Nonmydriatic fundus photograph — 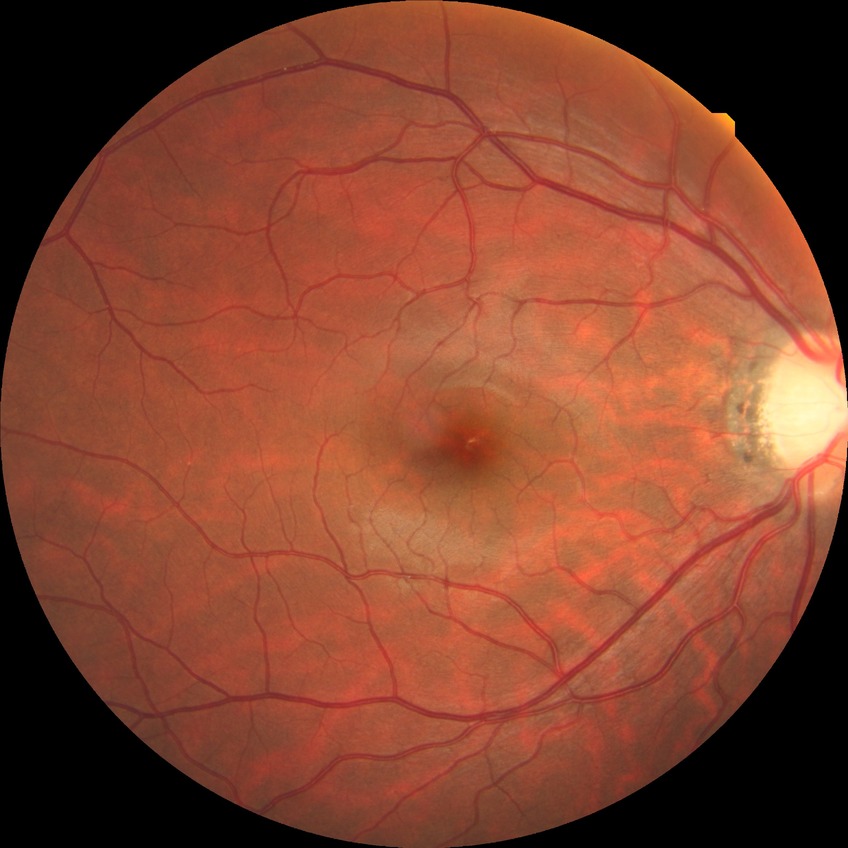 diabetic retinopathy (DR) = no diabetic retinopathy (NDR).